45° FOV, 848x848, NIDEK AFC-230 fundus camera, posterior pole color fundus photograph.
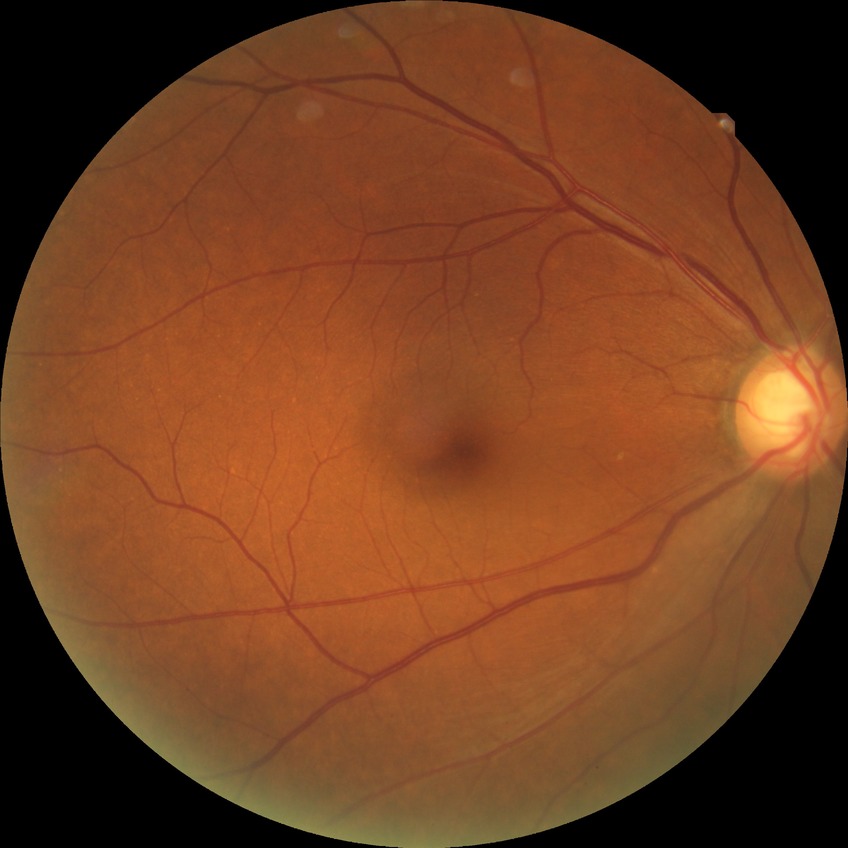
Diabetic retinopathy severity is no diabetic retinopathy.